Posterior pole photograph. NIDEK AFC-230.
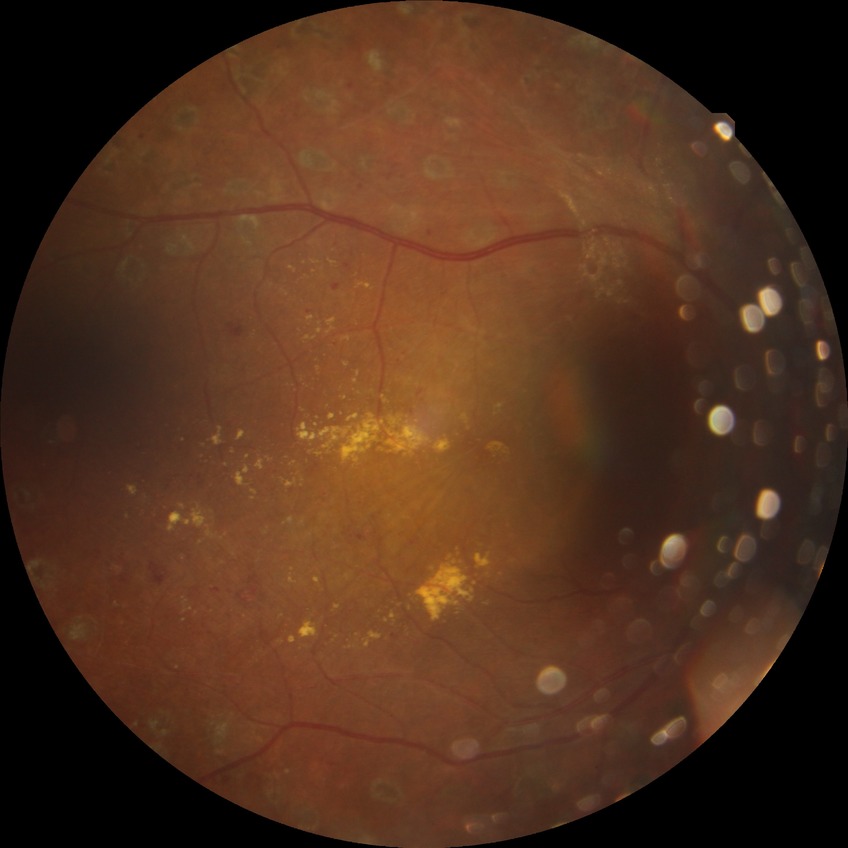

diabetic retinopathy severity: proliferative diabetic retinopathy